RetCam wide-field infant fundus image. 640 x 480 pixels.
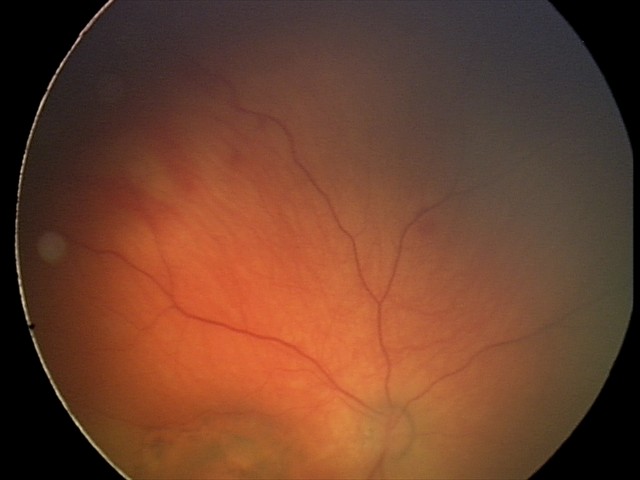

Q: What is the screening diagnosis?
A: toxoplasmosis chorioretinitis